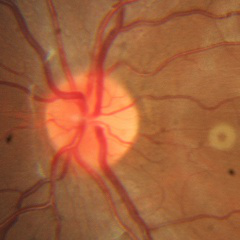 There is evidence of no glaucomatous findings.